2102x1736, CFP: 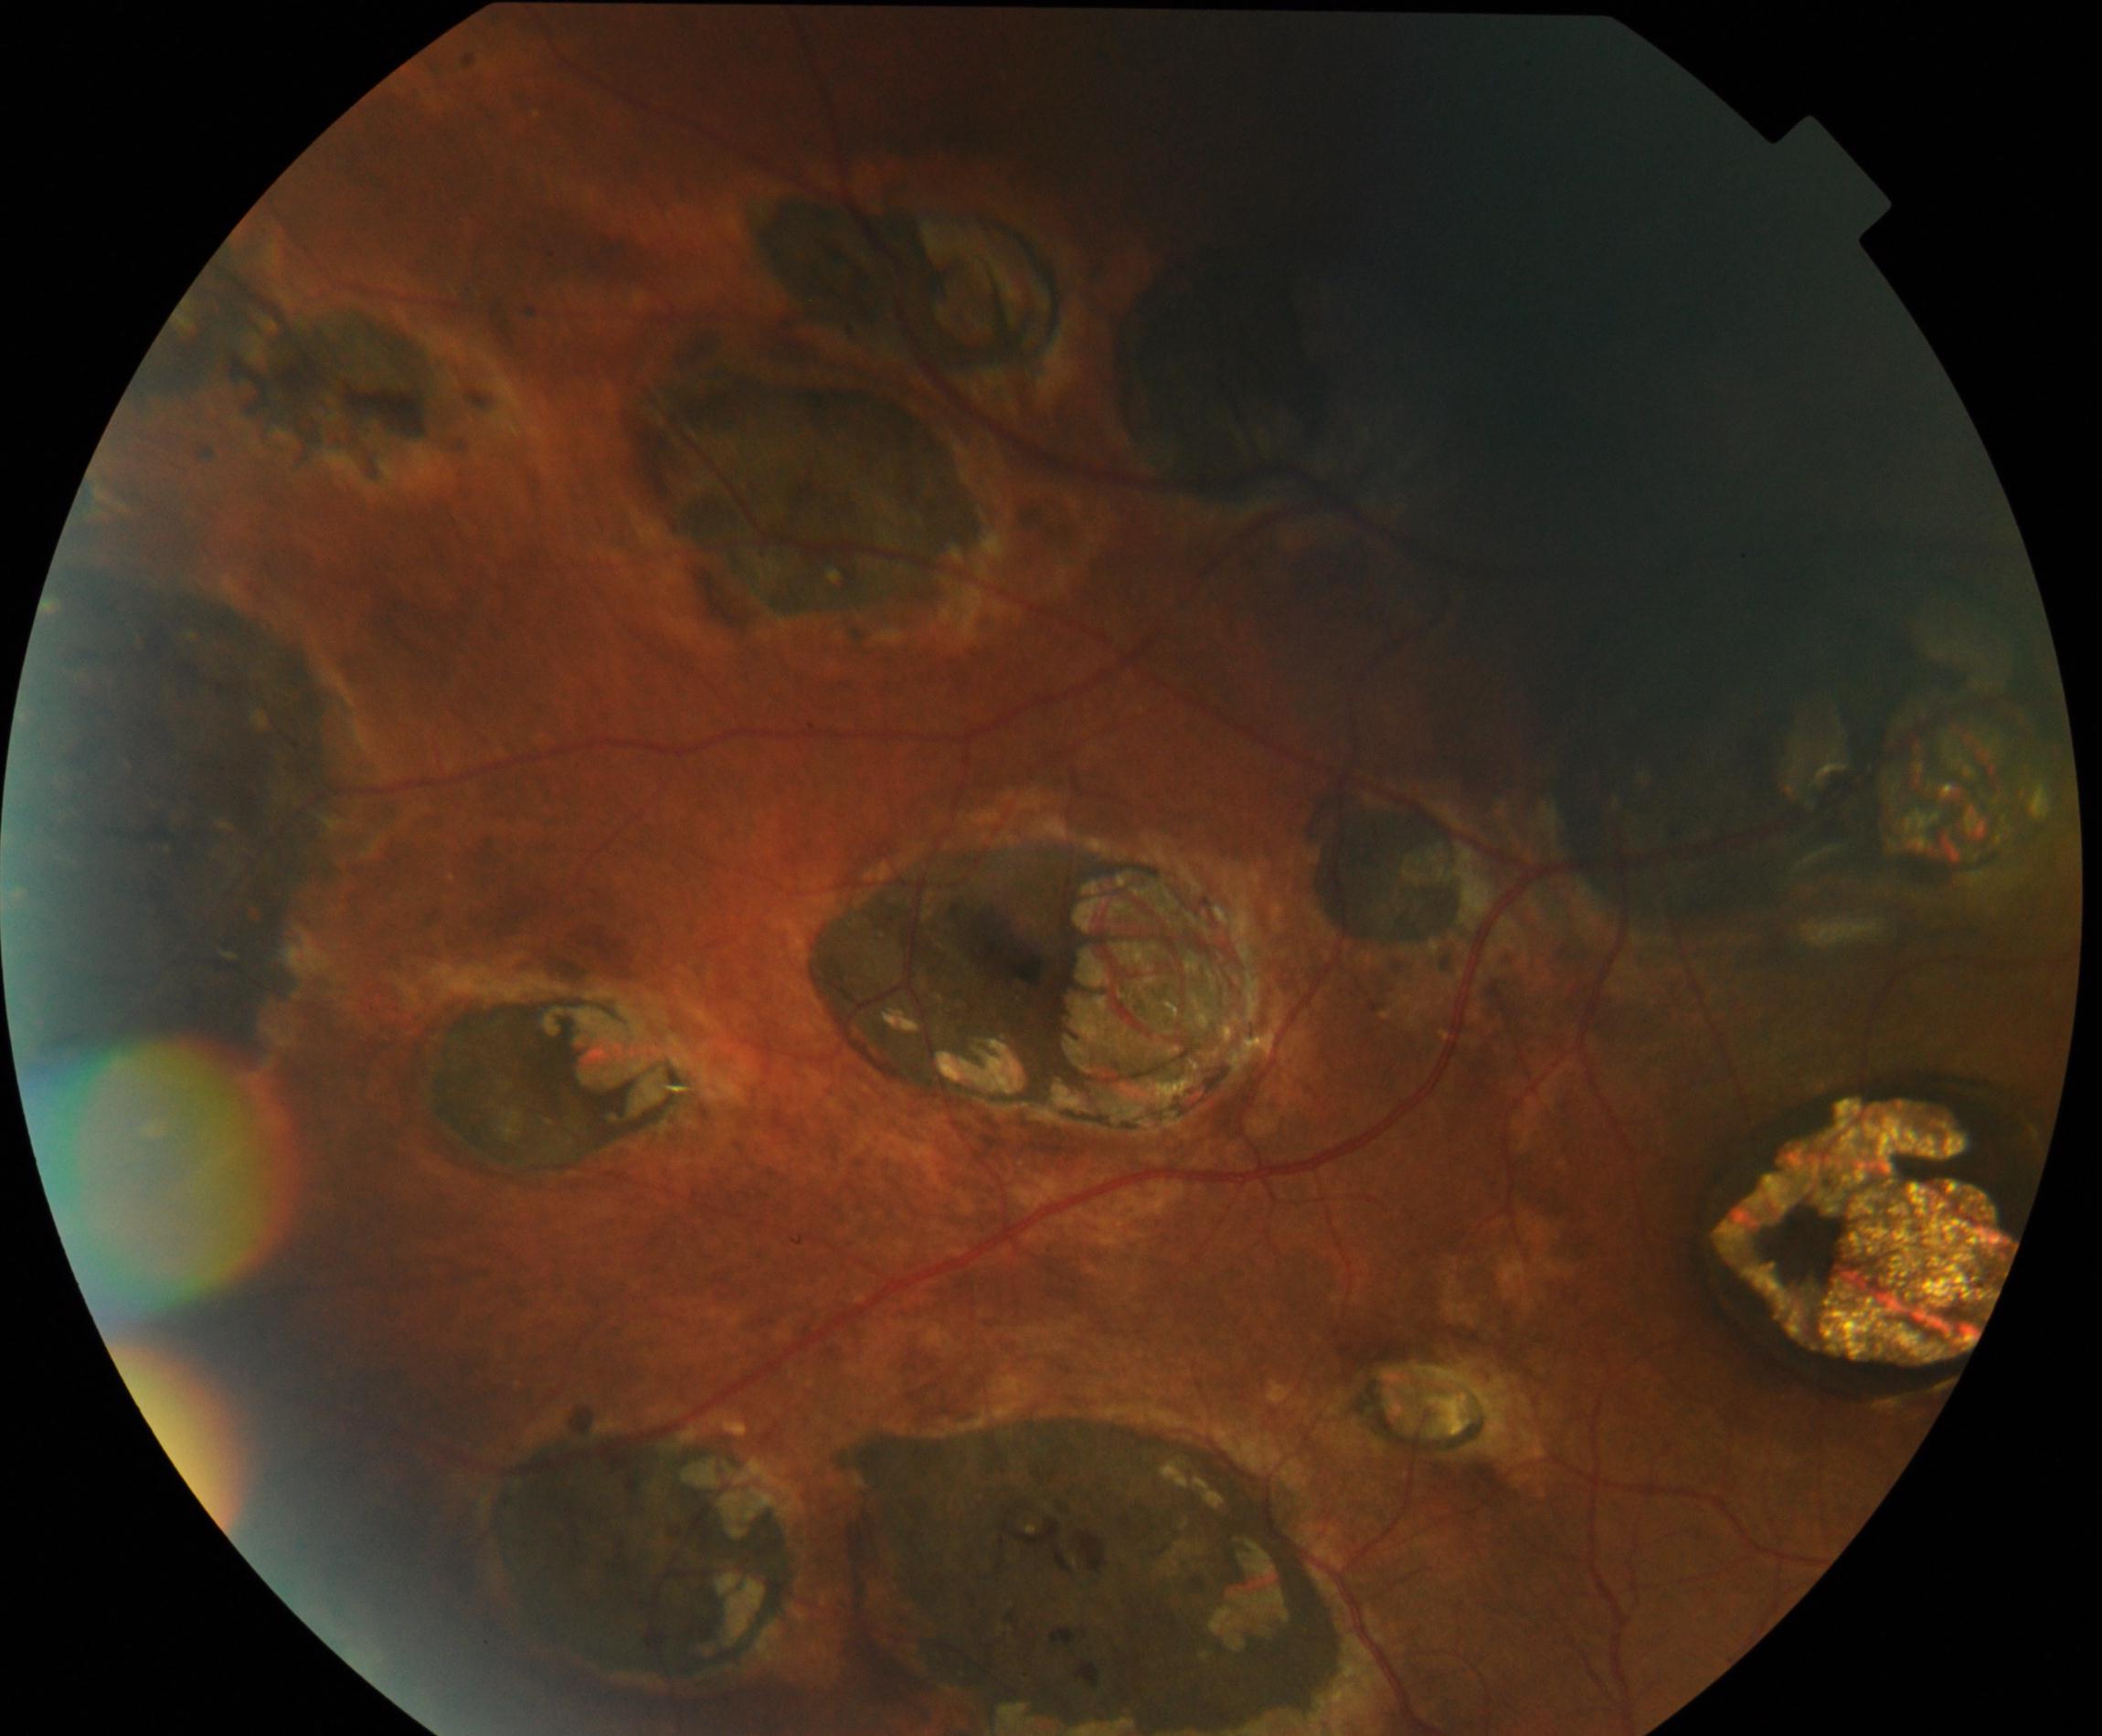 Consistent with chorioretinal atrophy or coloboma.